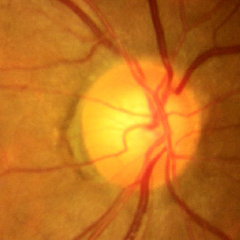

Fundus image with findings of no signs of glaucoma.